Wide-field fundus photograph of an infant; 1240 by 1240 pixels; acquired on the Phoenix ICON — 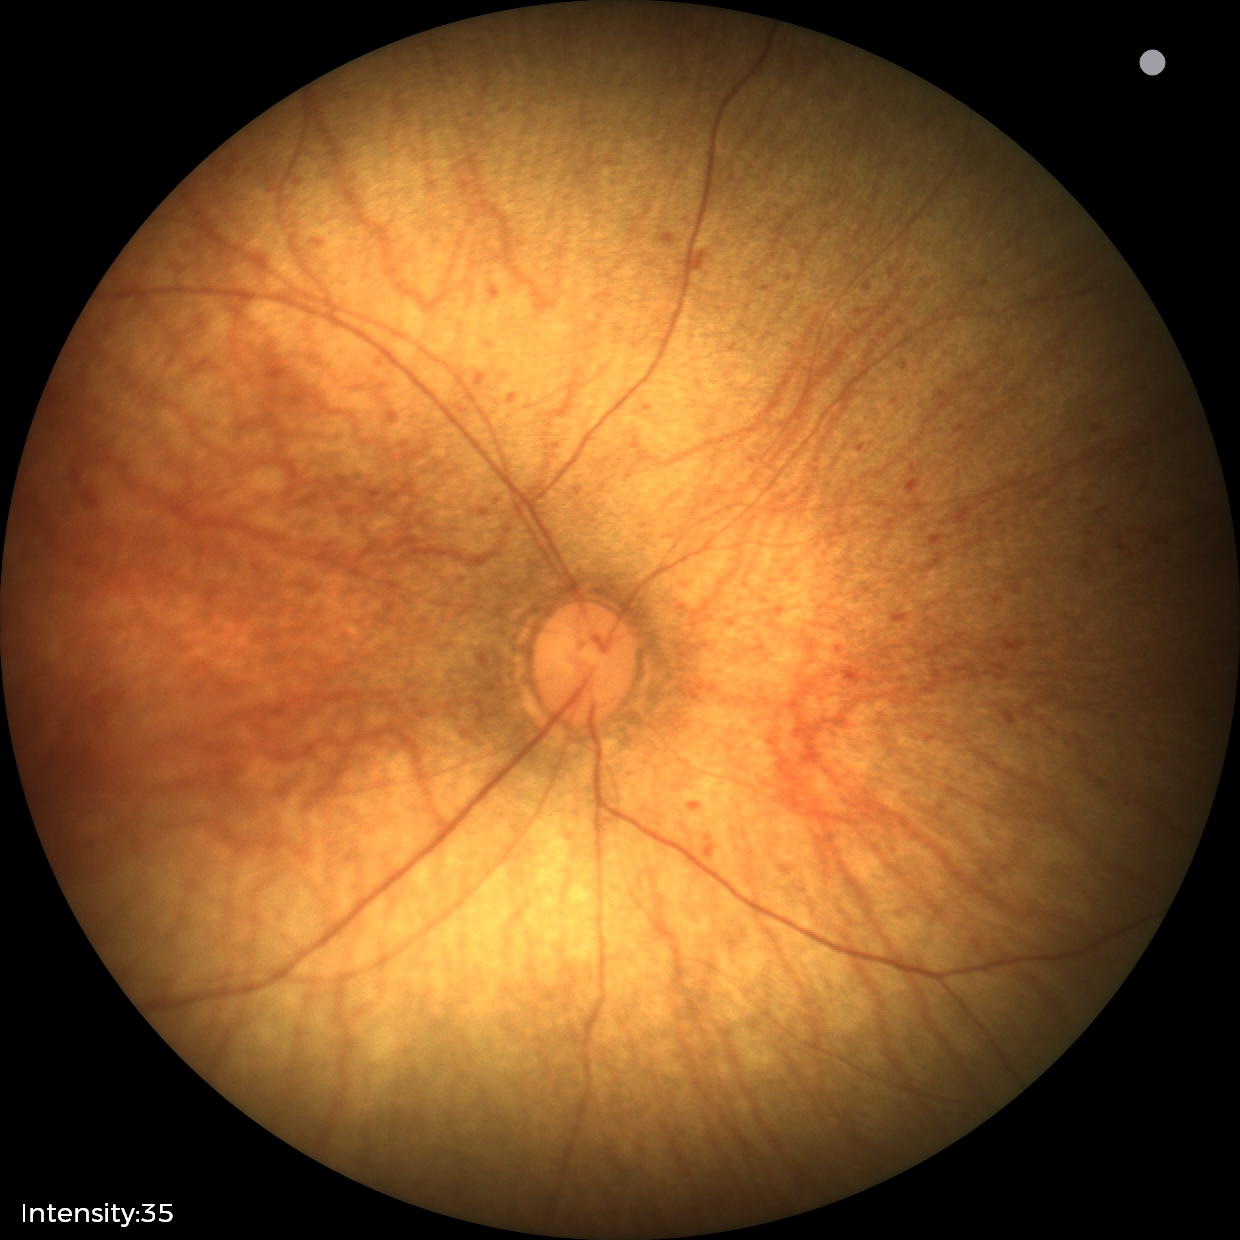

Normal screening examination.